1515x1275px
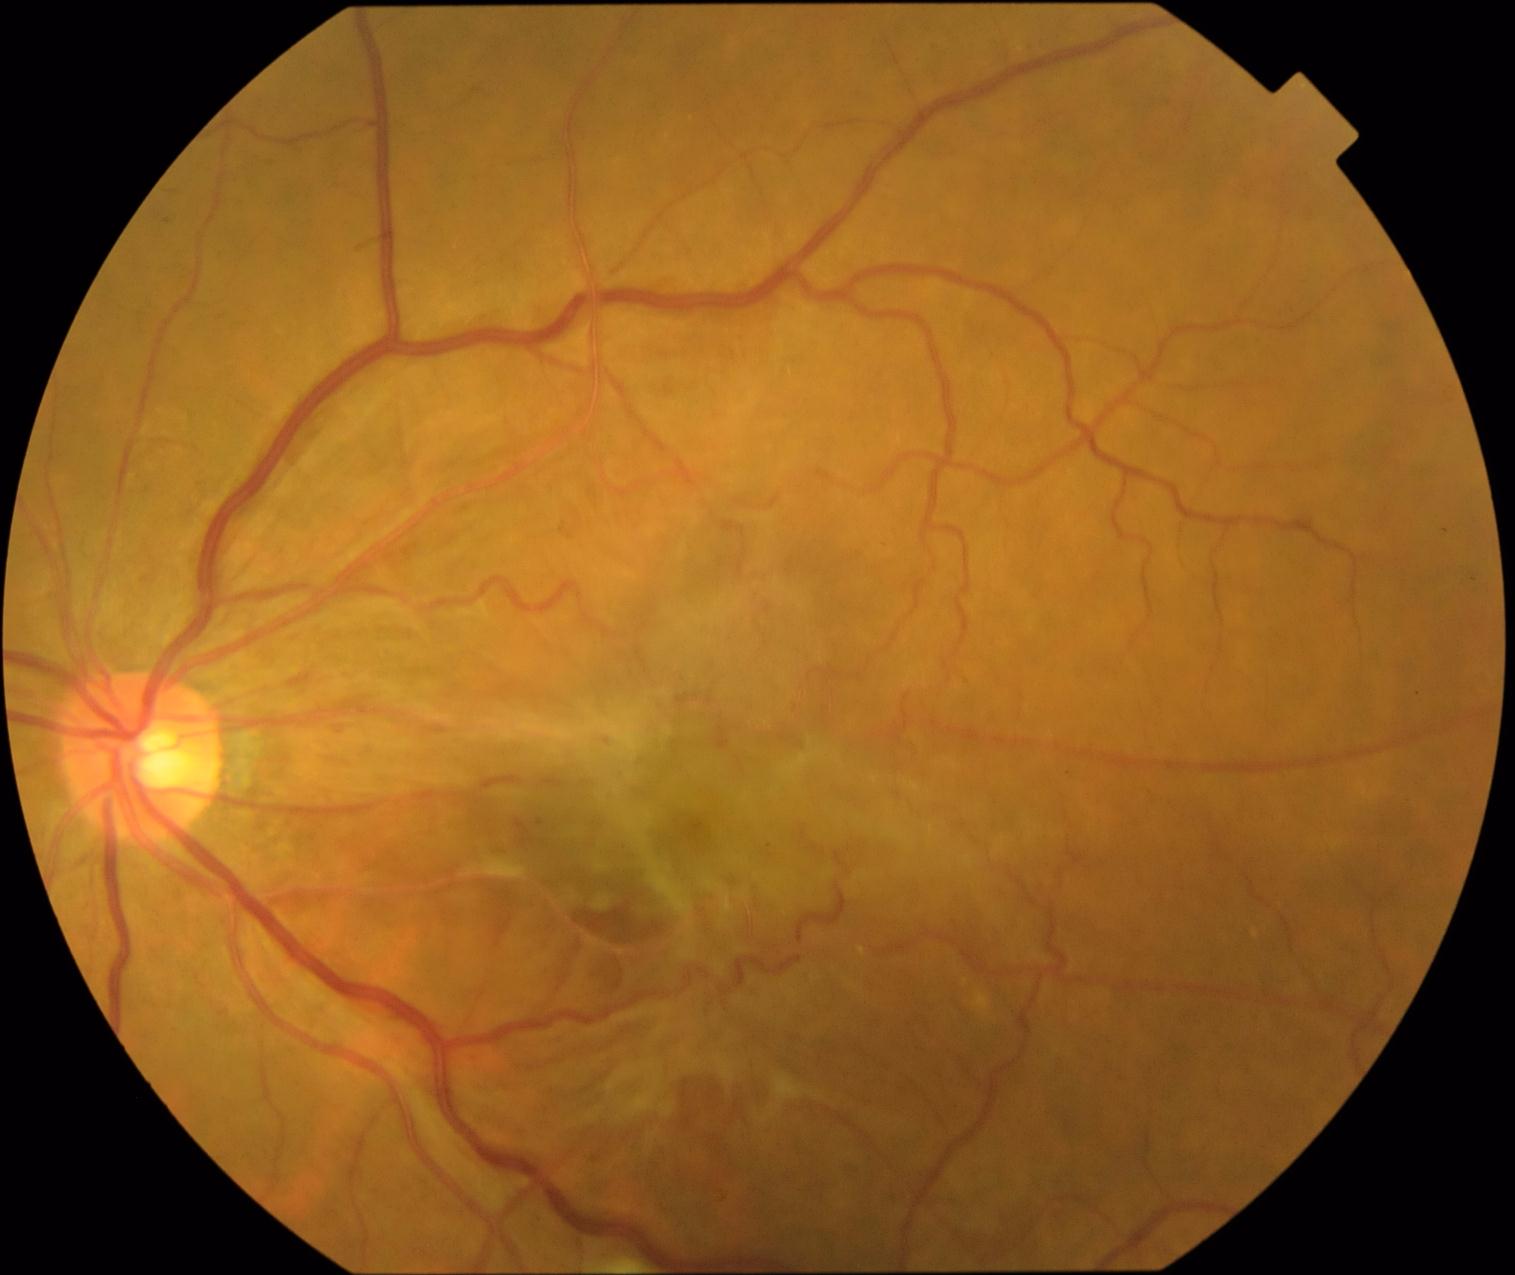

  dr_grade: 4/4